512x512px; CFP
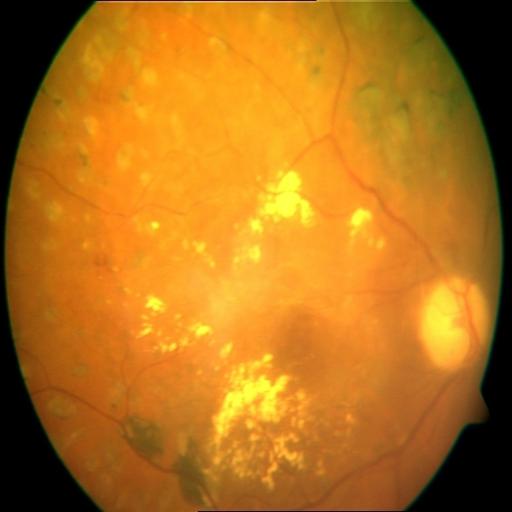

There is evidence of laser scars (LS), exudation (EDN), and cystoid macular edema (CME).